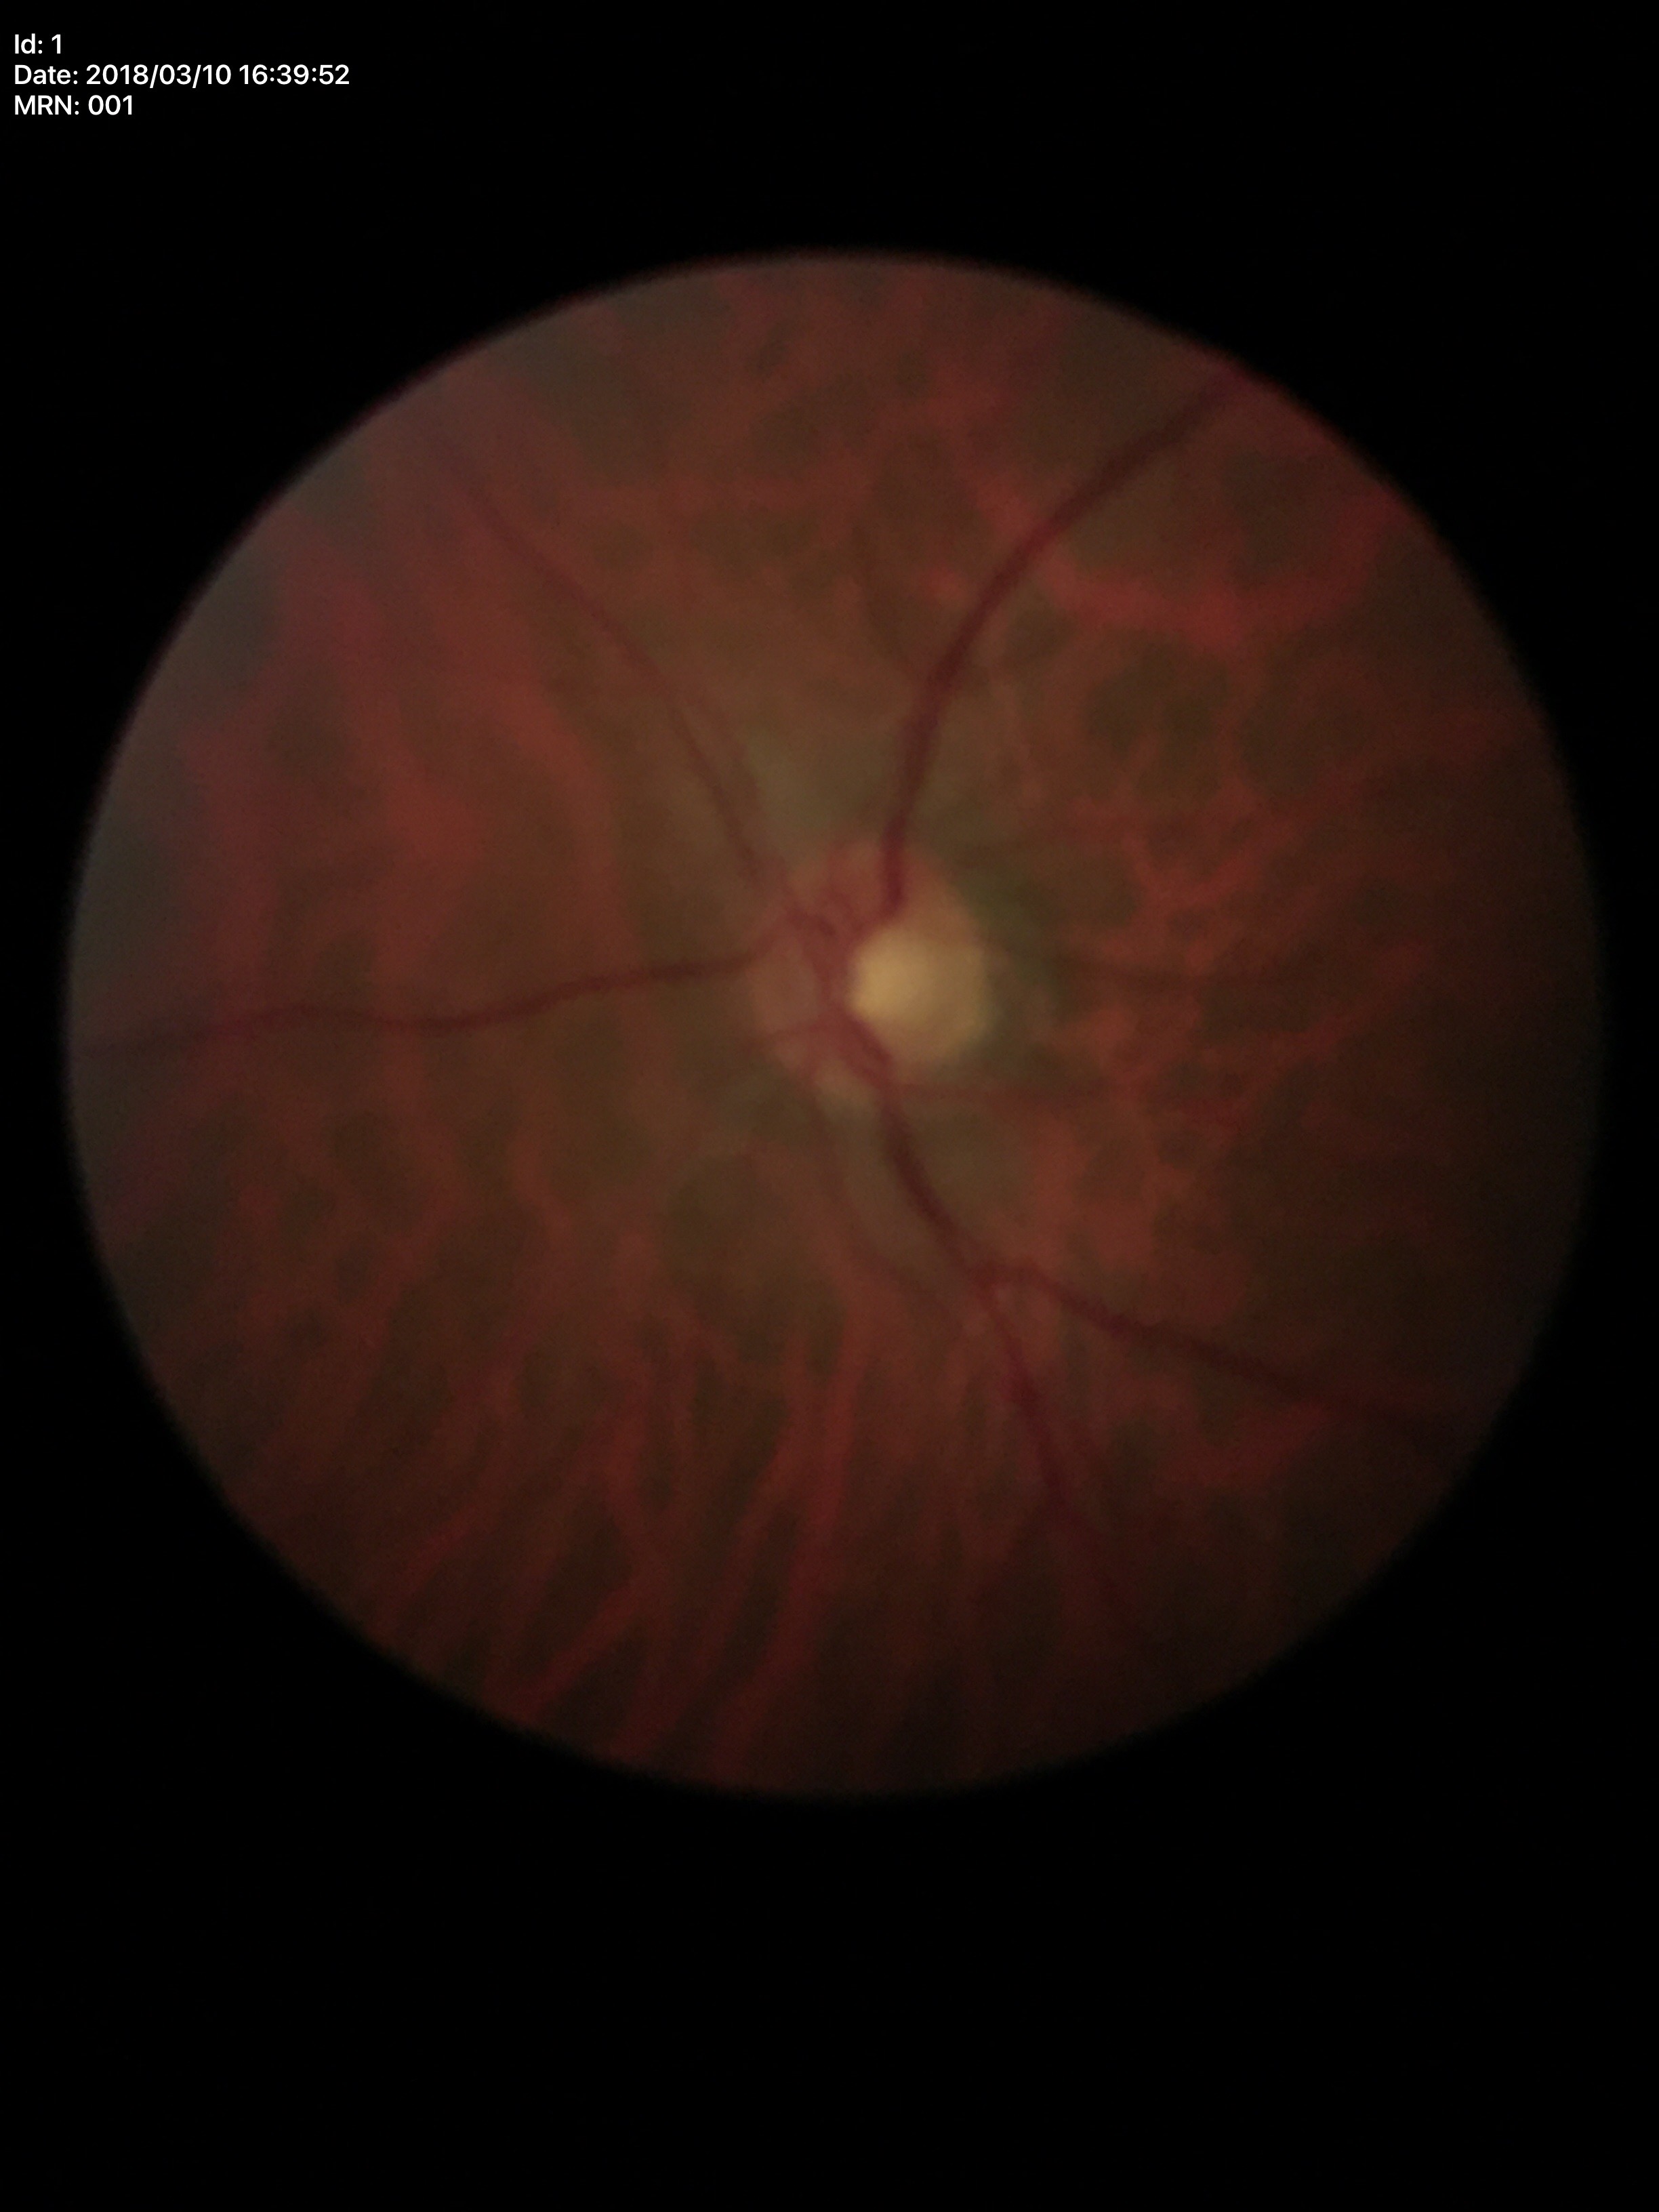 {
  "glaucoma_decision": "negative",
  "vcdr": "0.50"
}